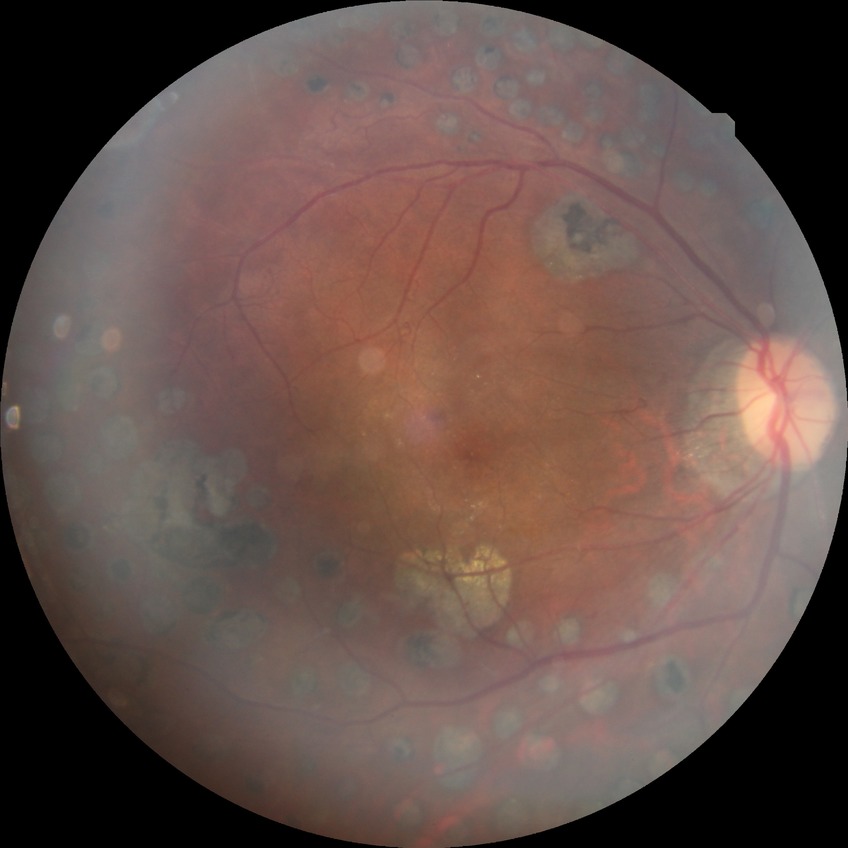
Davis stage: PDR.